2228x1652:
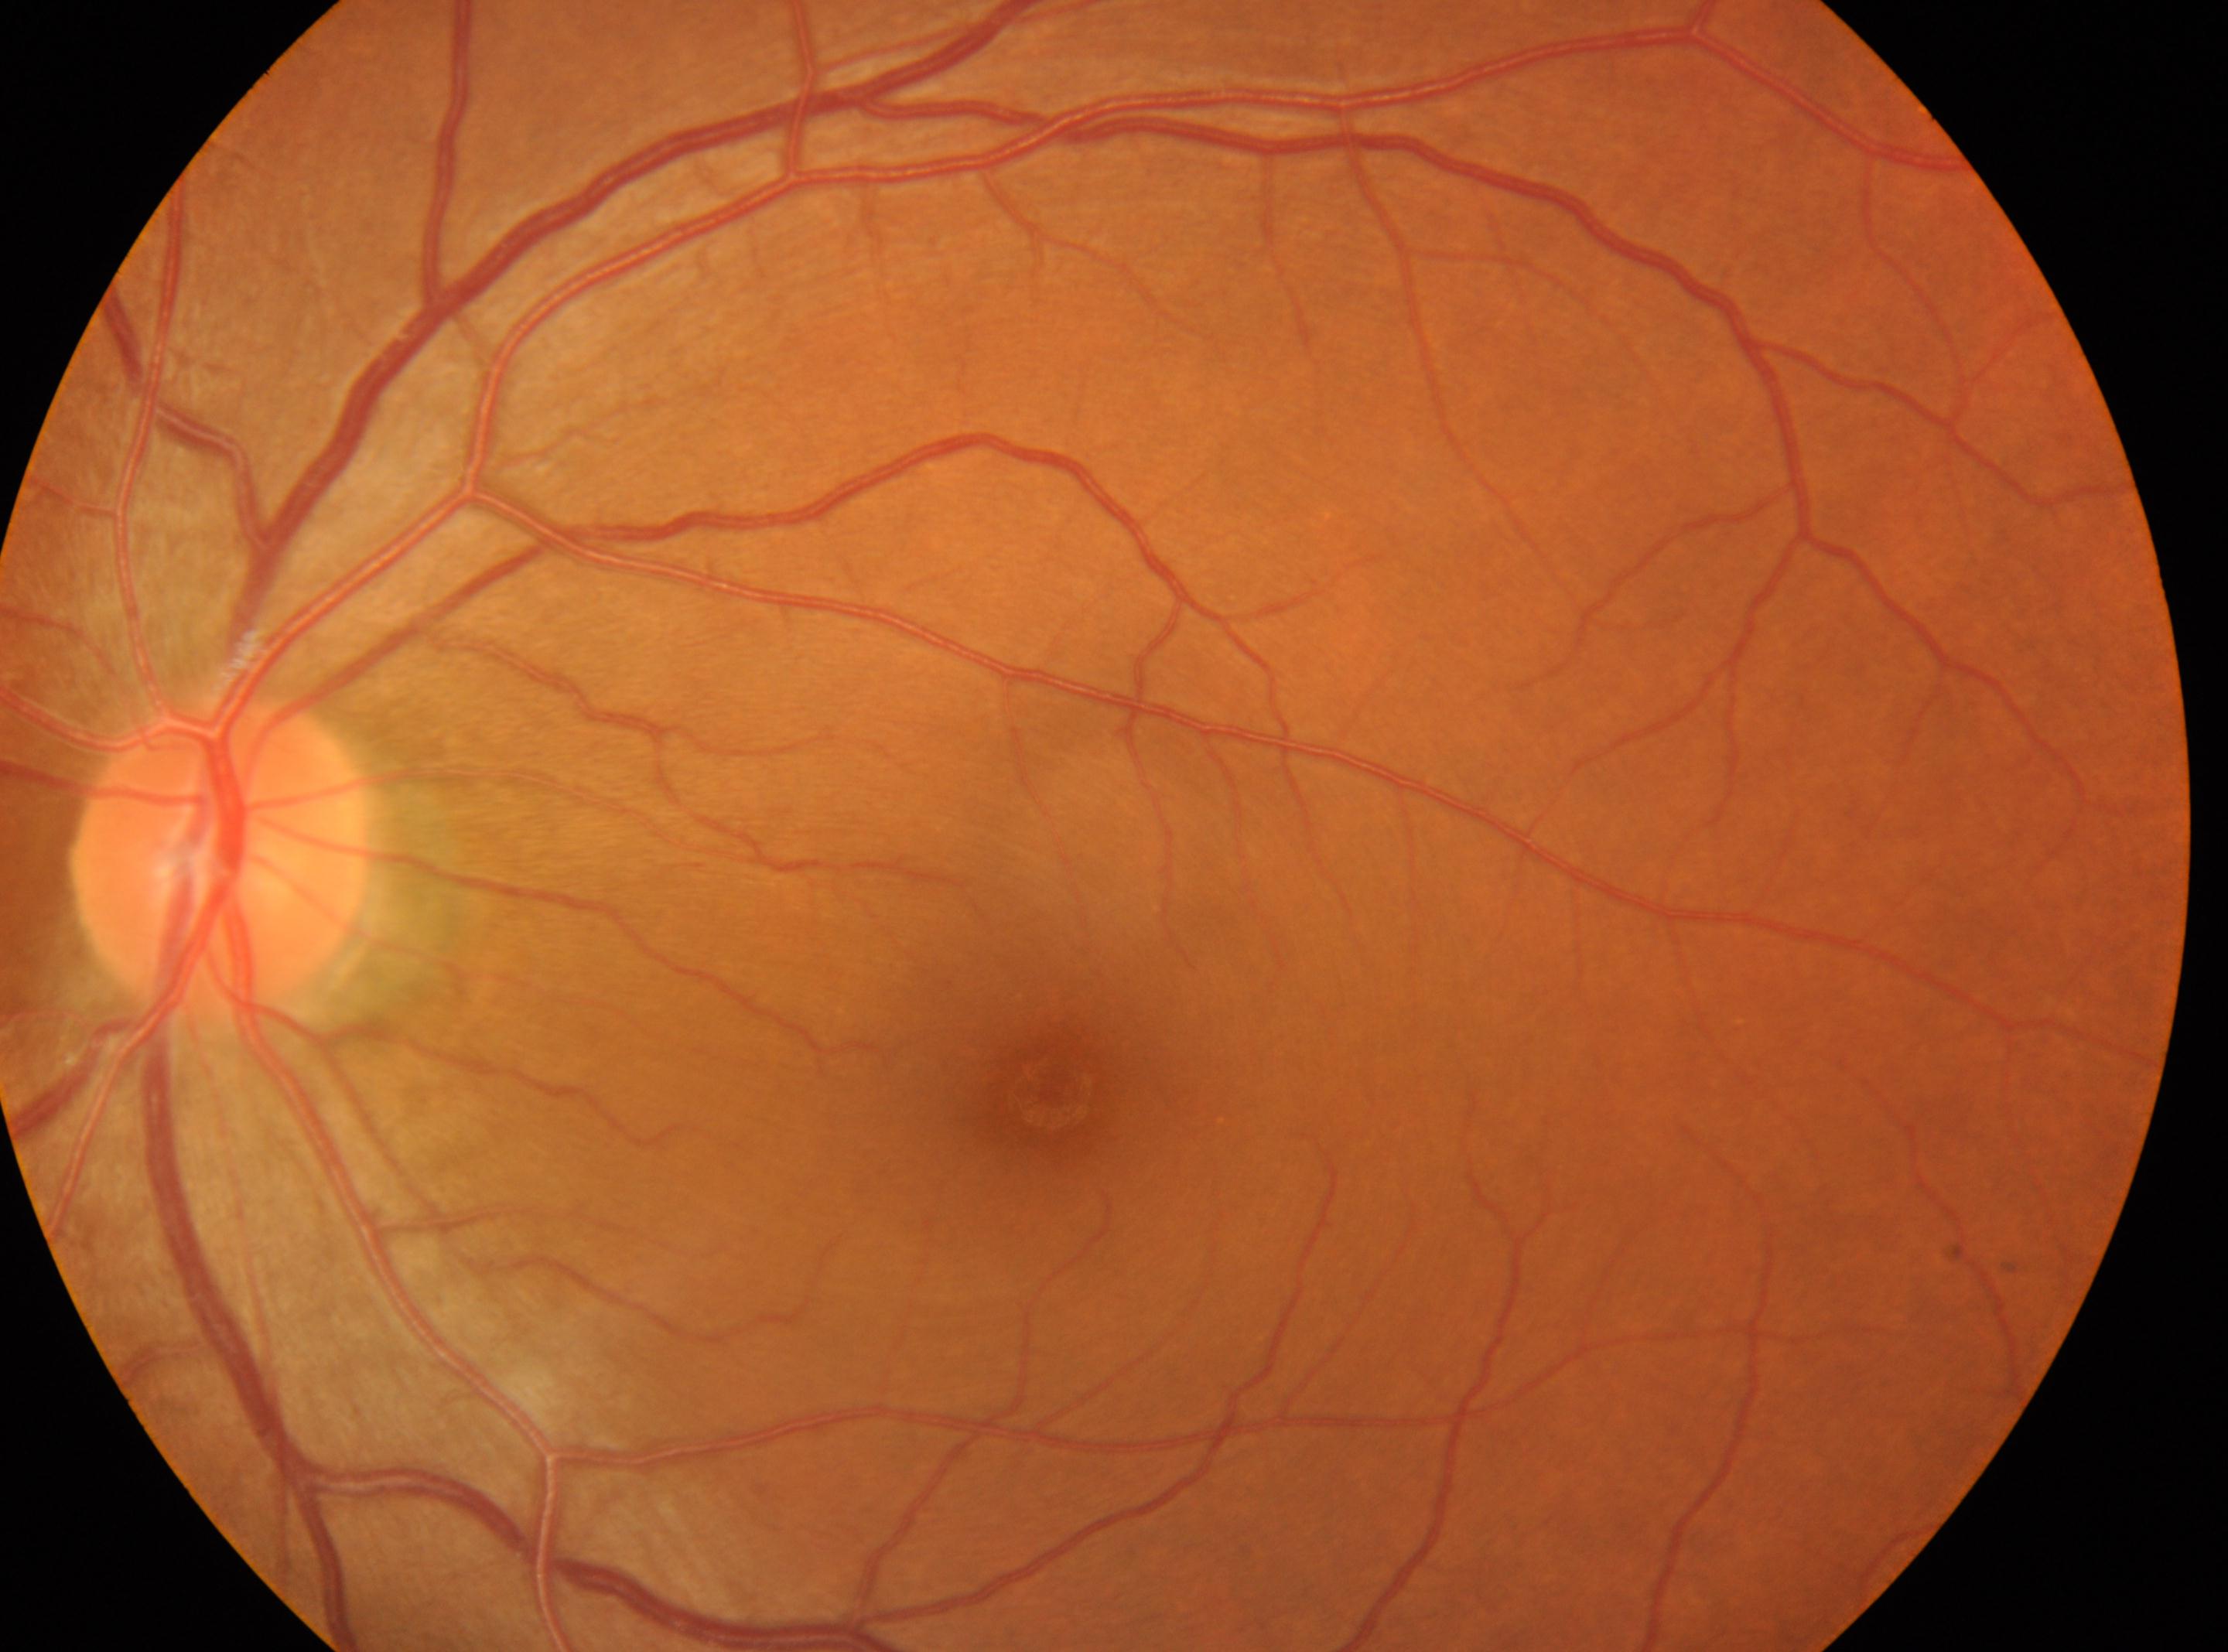
This is the OS. The fovea is at (x: 1051, y: 1087). Optic disc located at (x: 220, y: 856). DR stage is no apparent diabetic retinopathy (grade 0). No apparent diabetic retinopathy.